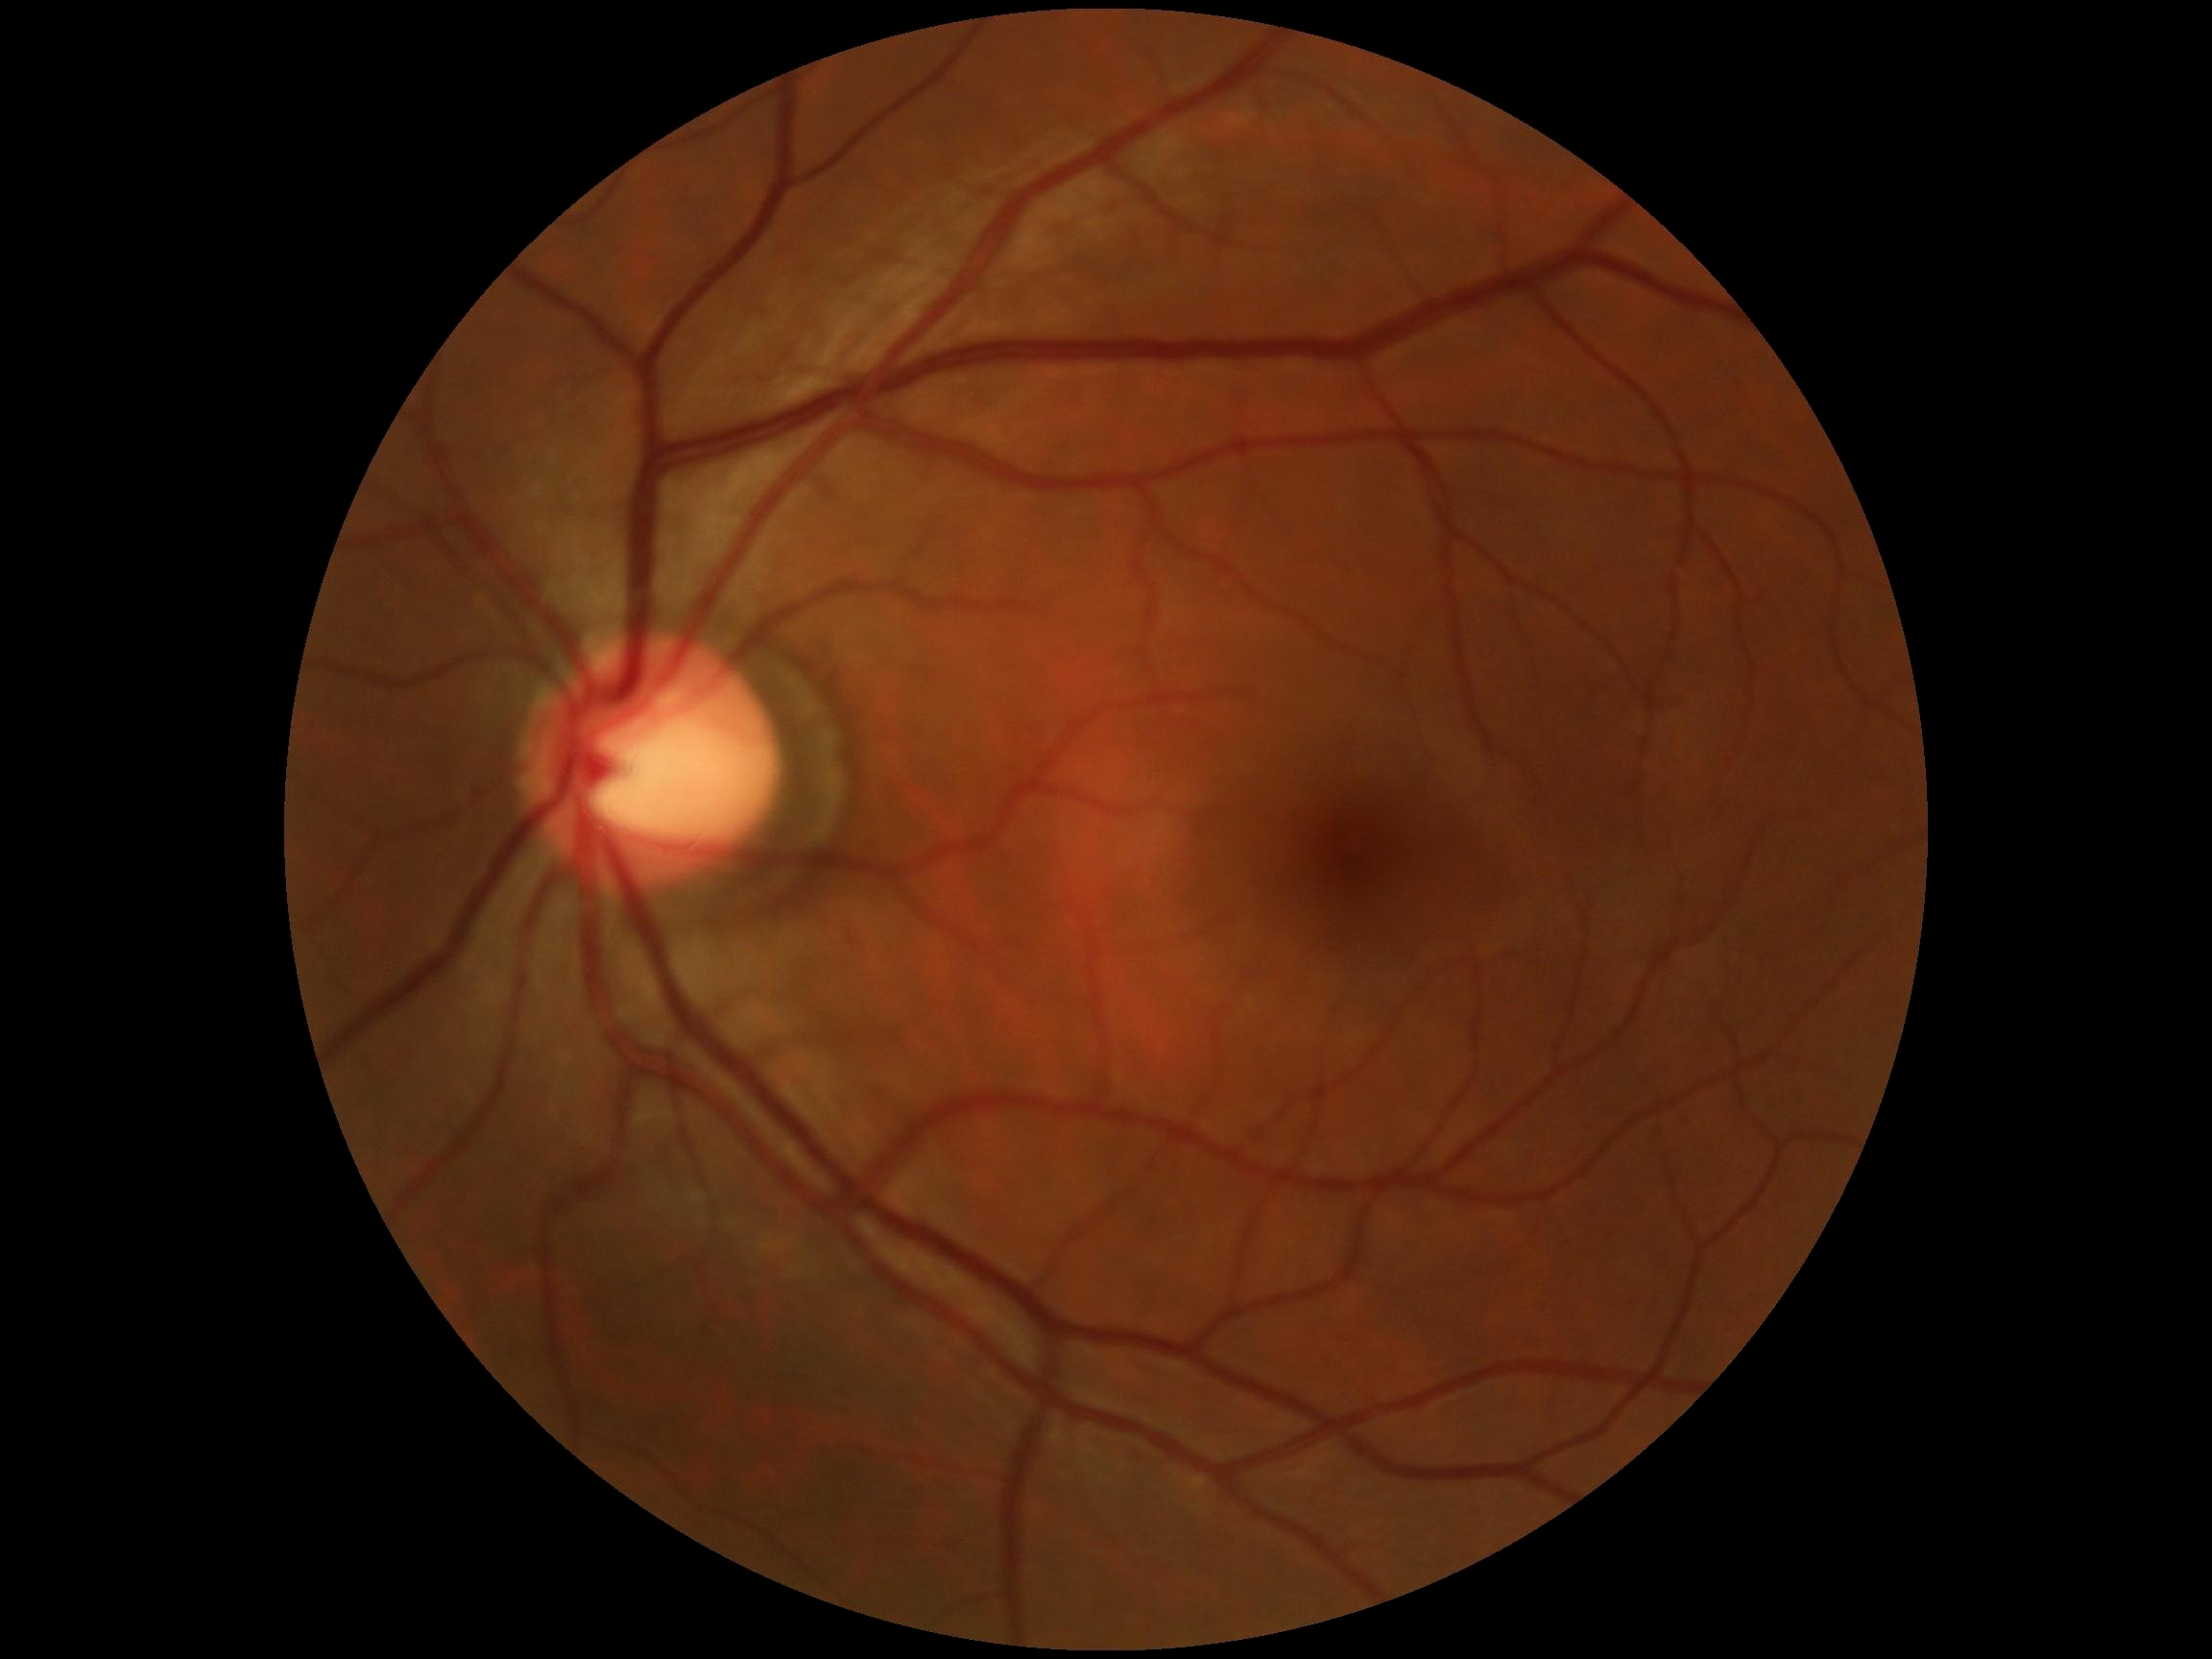

Retinopathy: grade 0 (no apparent retinopathy).